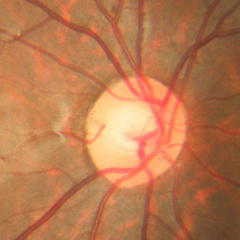

Q: What stage of glaucoma is present?
A: No — no signs of glaucoma.